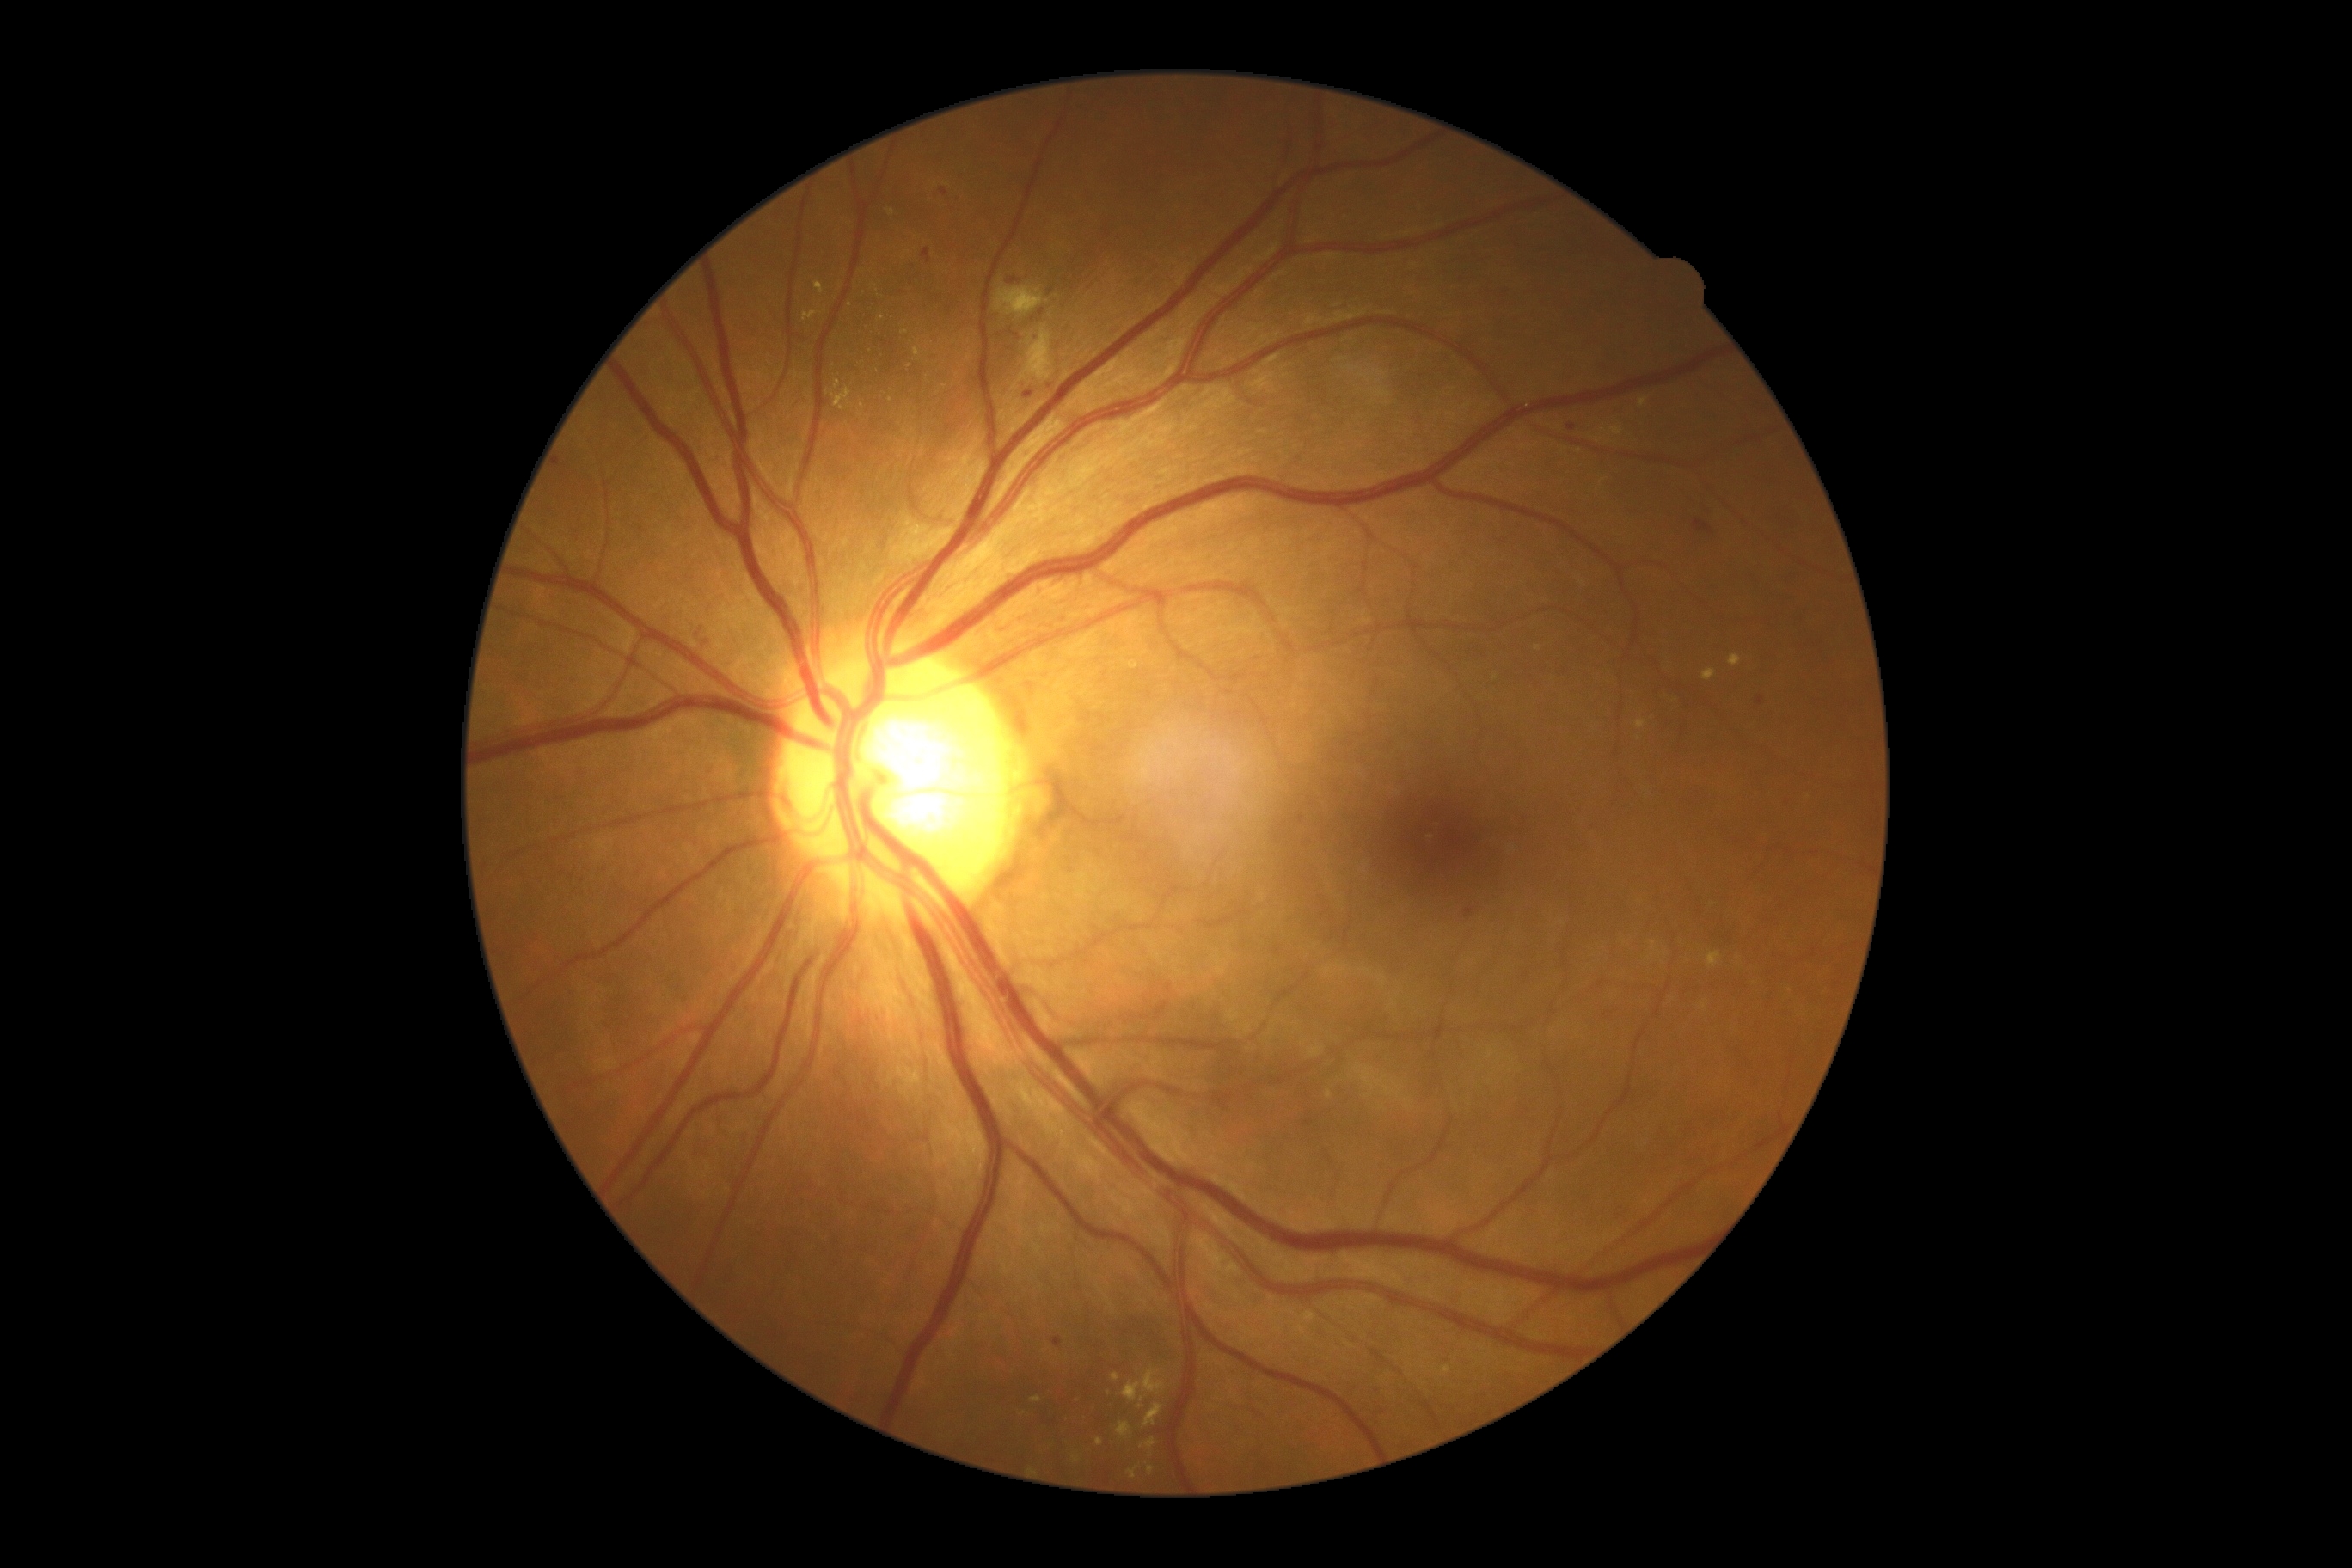
The retinopathy is classified as non-proliferative diabetic retinopathy. Retinopathy grade is 2 — more than just microaneurysms but less than severe NPDR.